1240x1240px. Pediatric retinal photograph (wide-field).
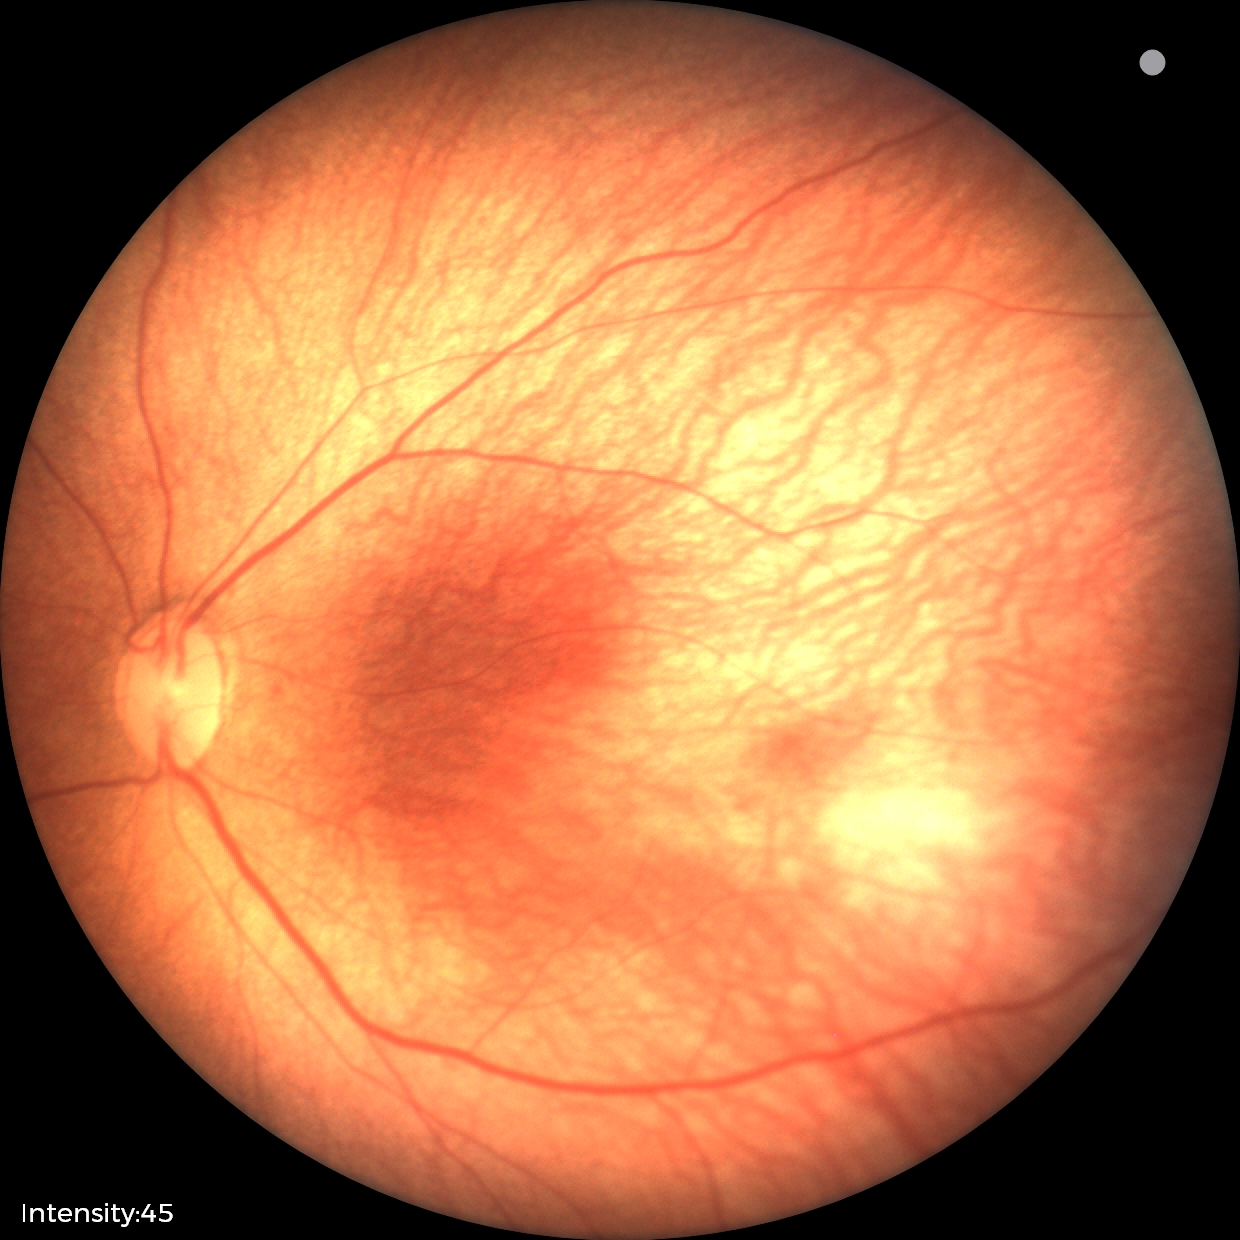

Diagnosis from this screening exam: ROP stage 1.
Without plus disease.